Image size 1536x1152: 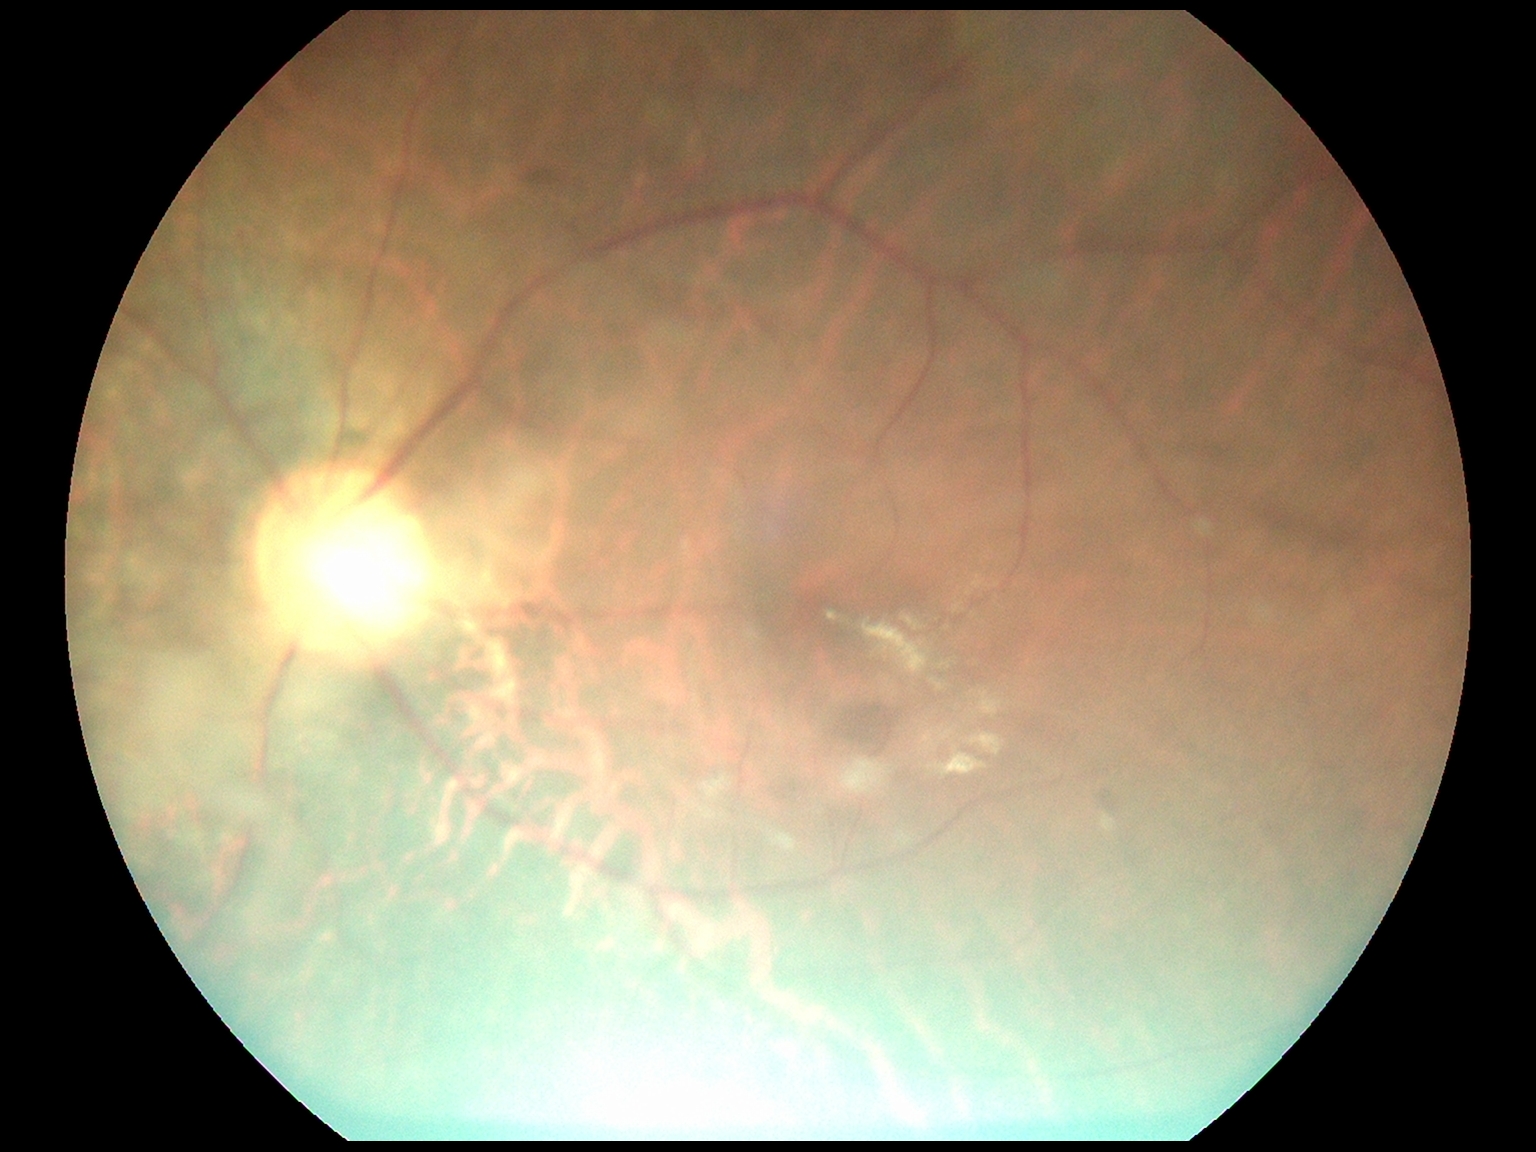

DR grade: 2/4.